Fundus photo
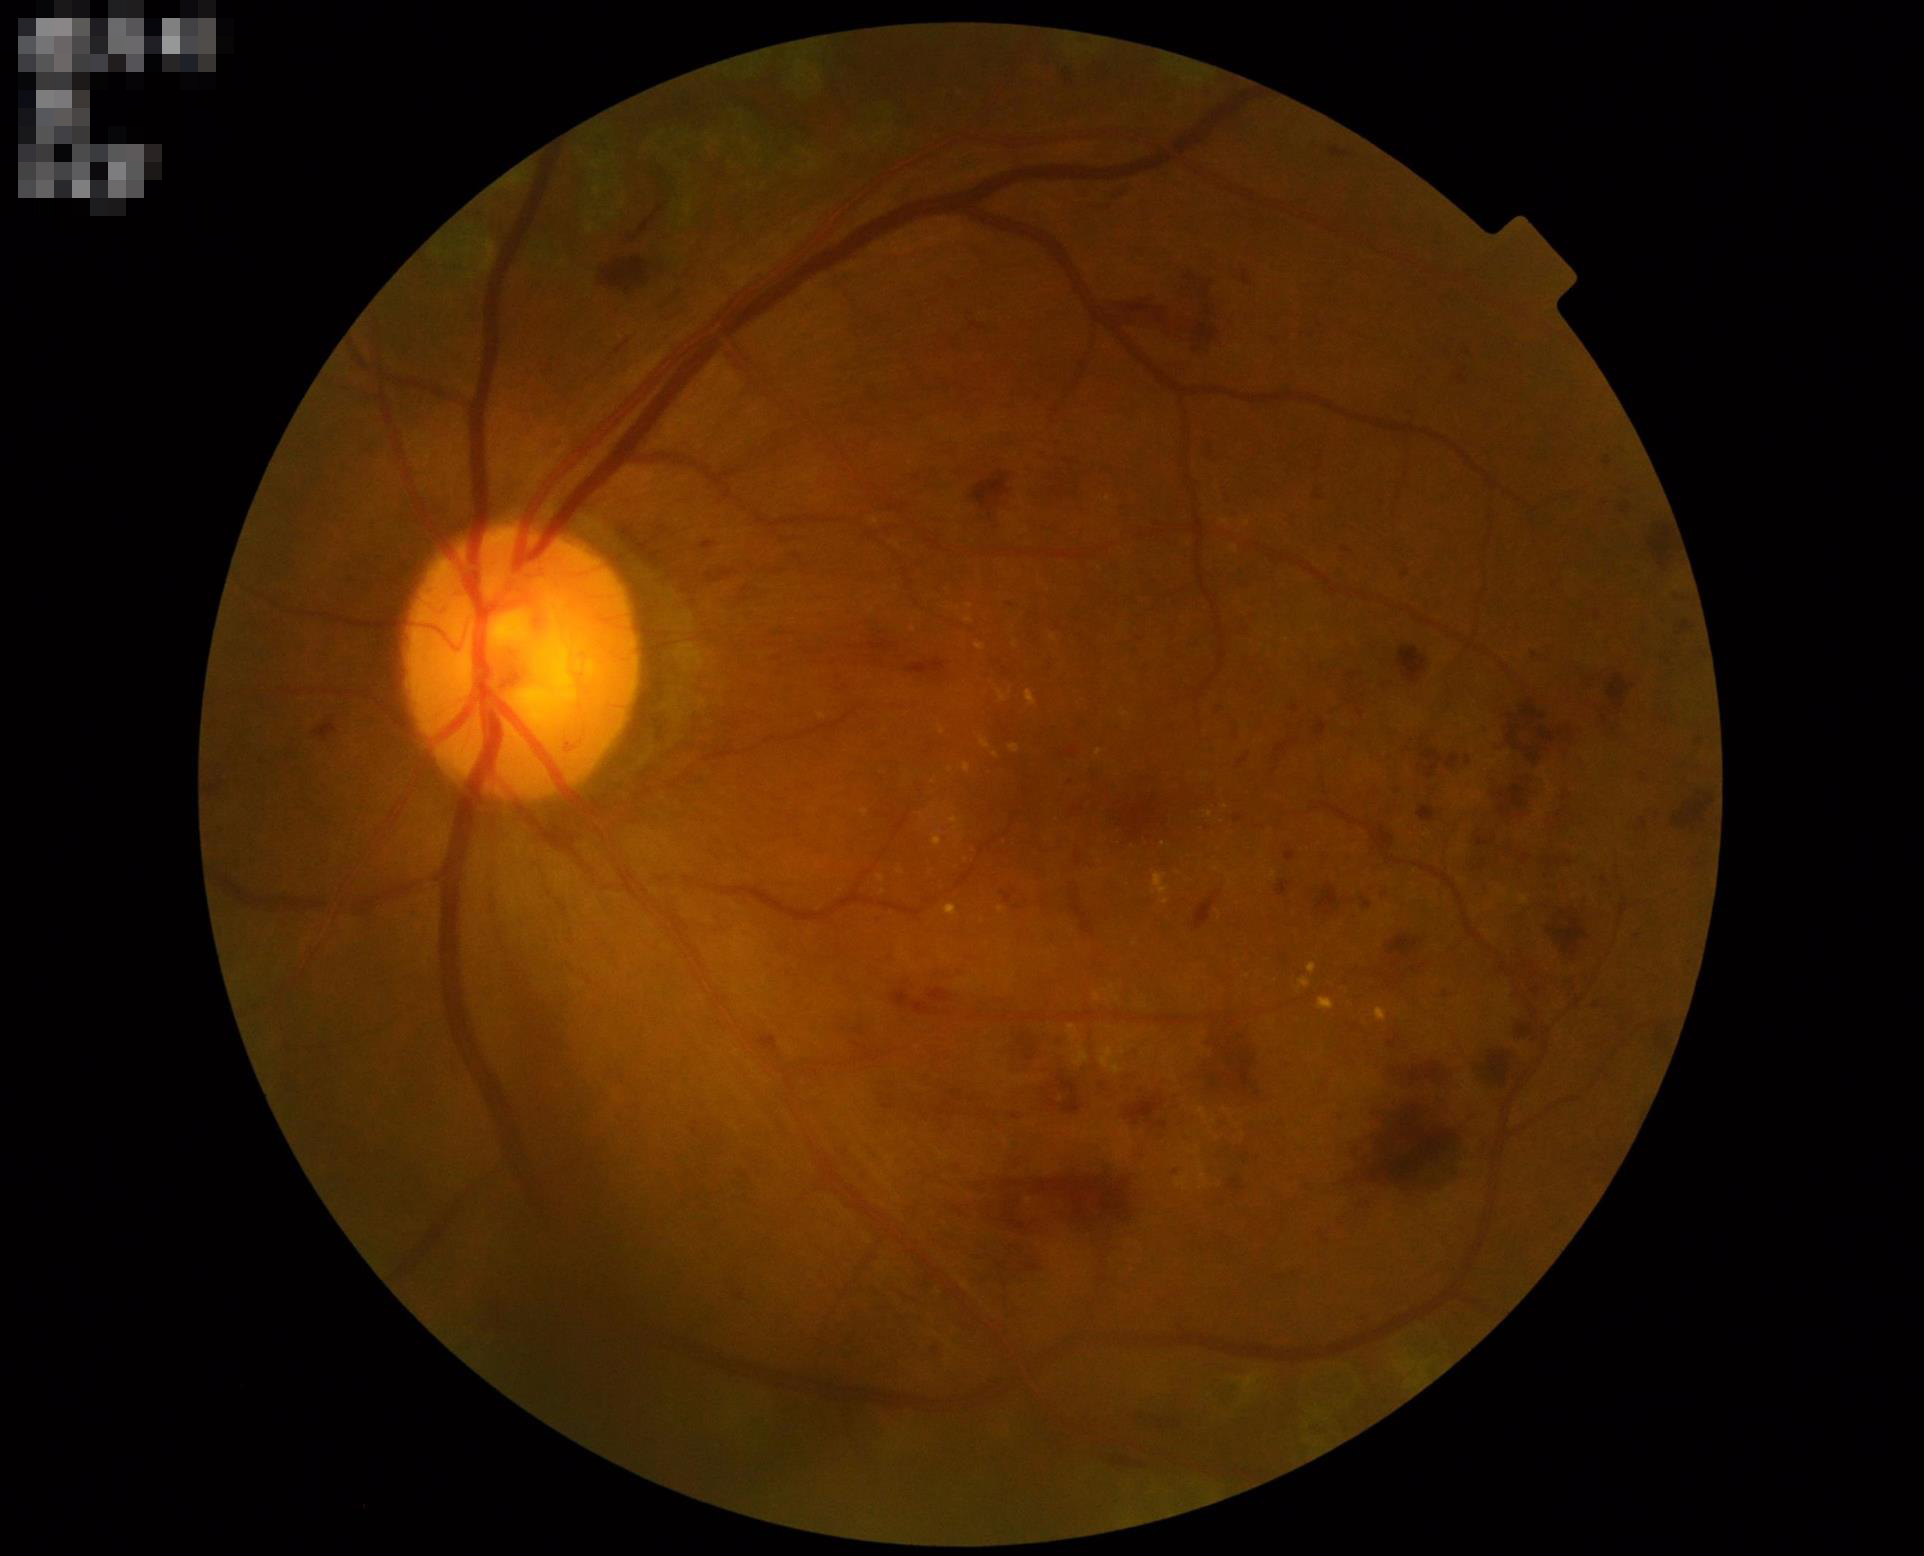

Quality grading:
- illumination/color: uniform, no color cast
- focus: clear with no noticeable blur
- overall: adequate for clinical interpretation